Color fundus image: 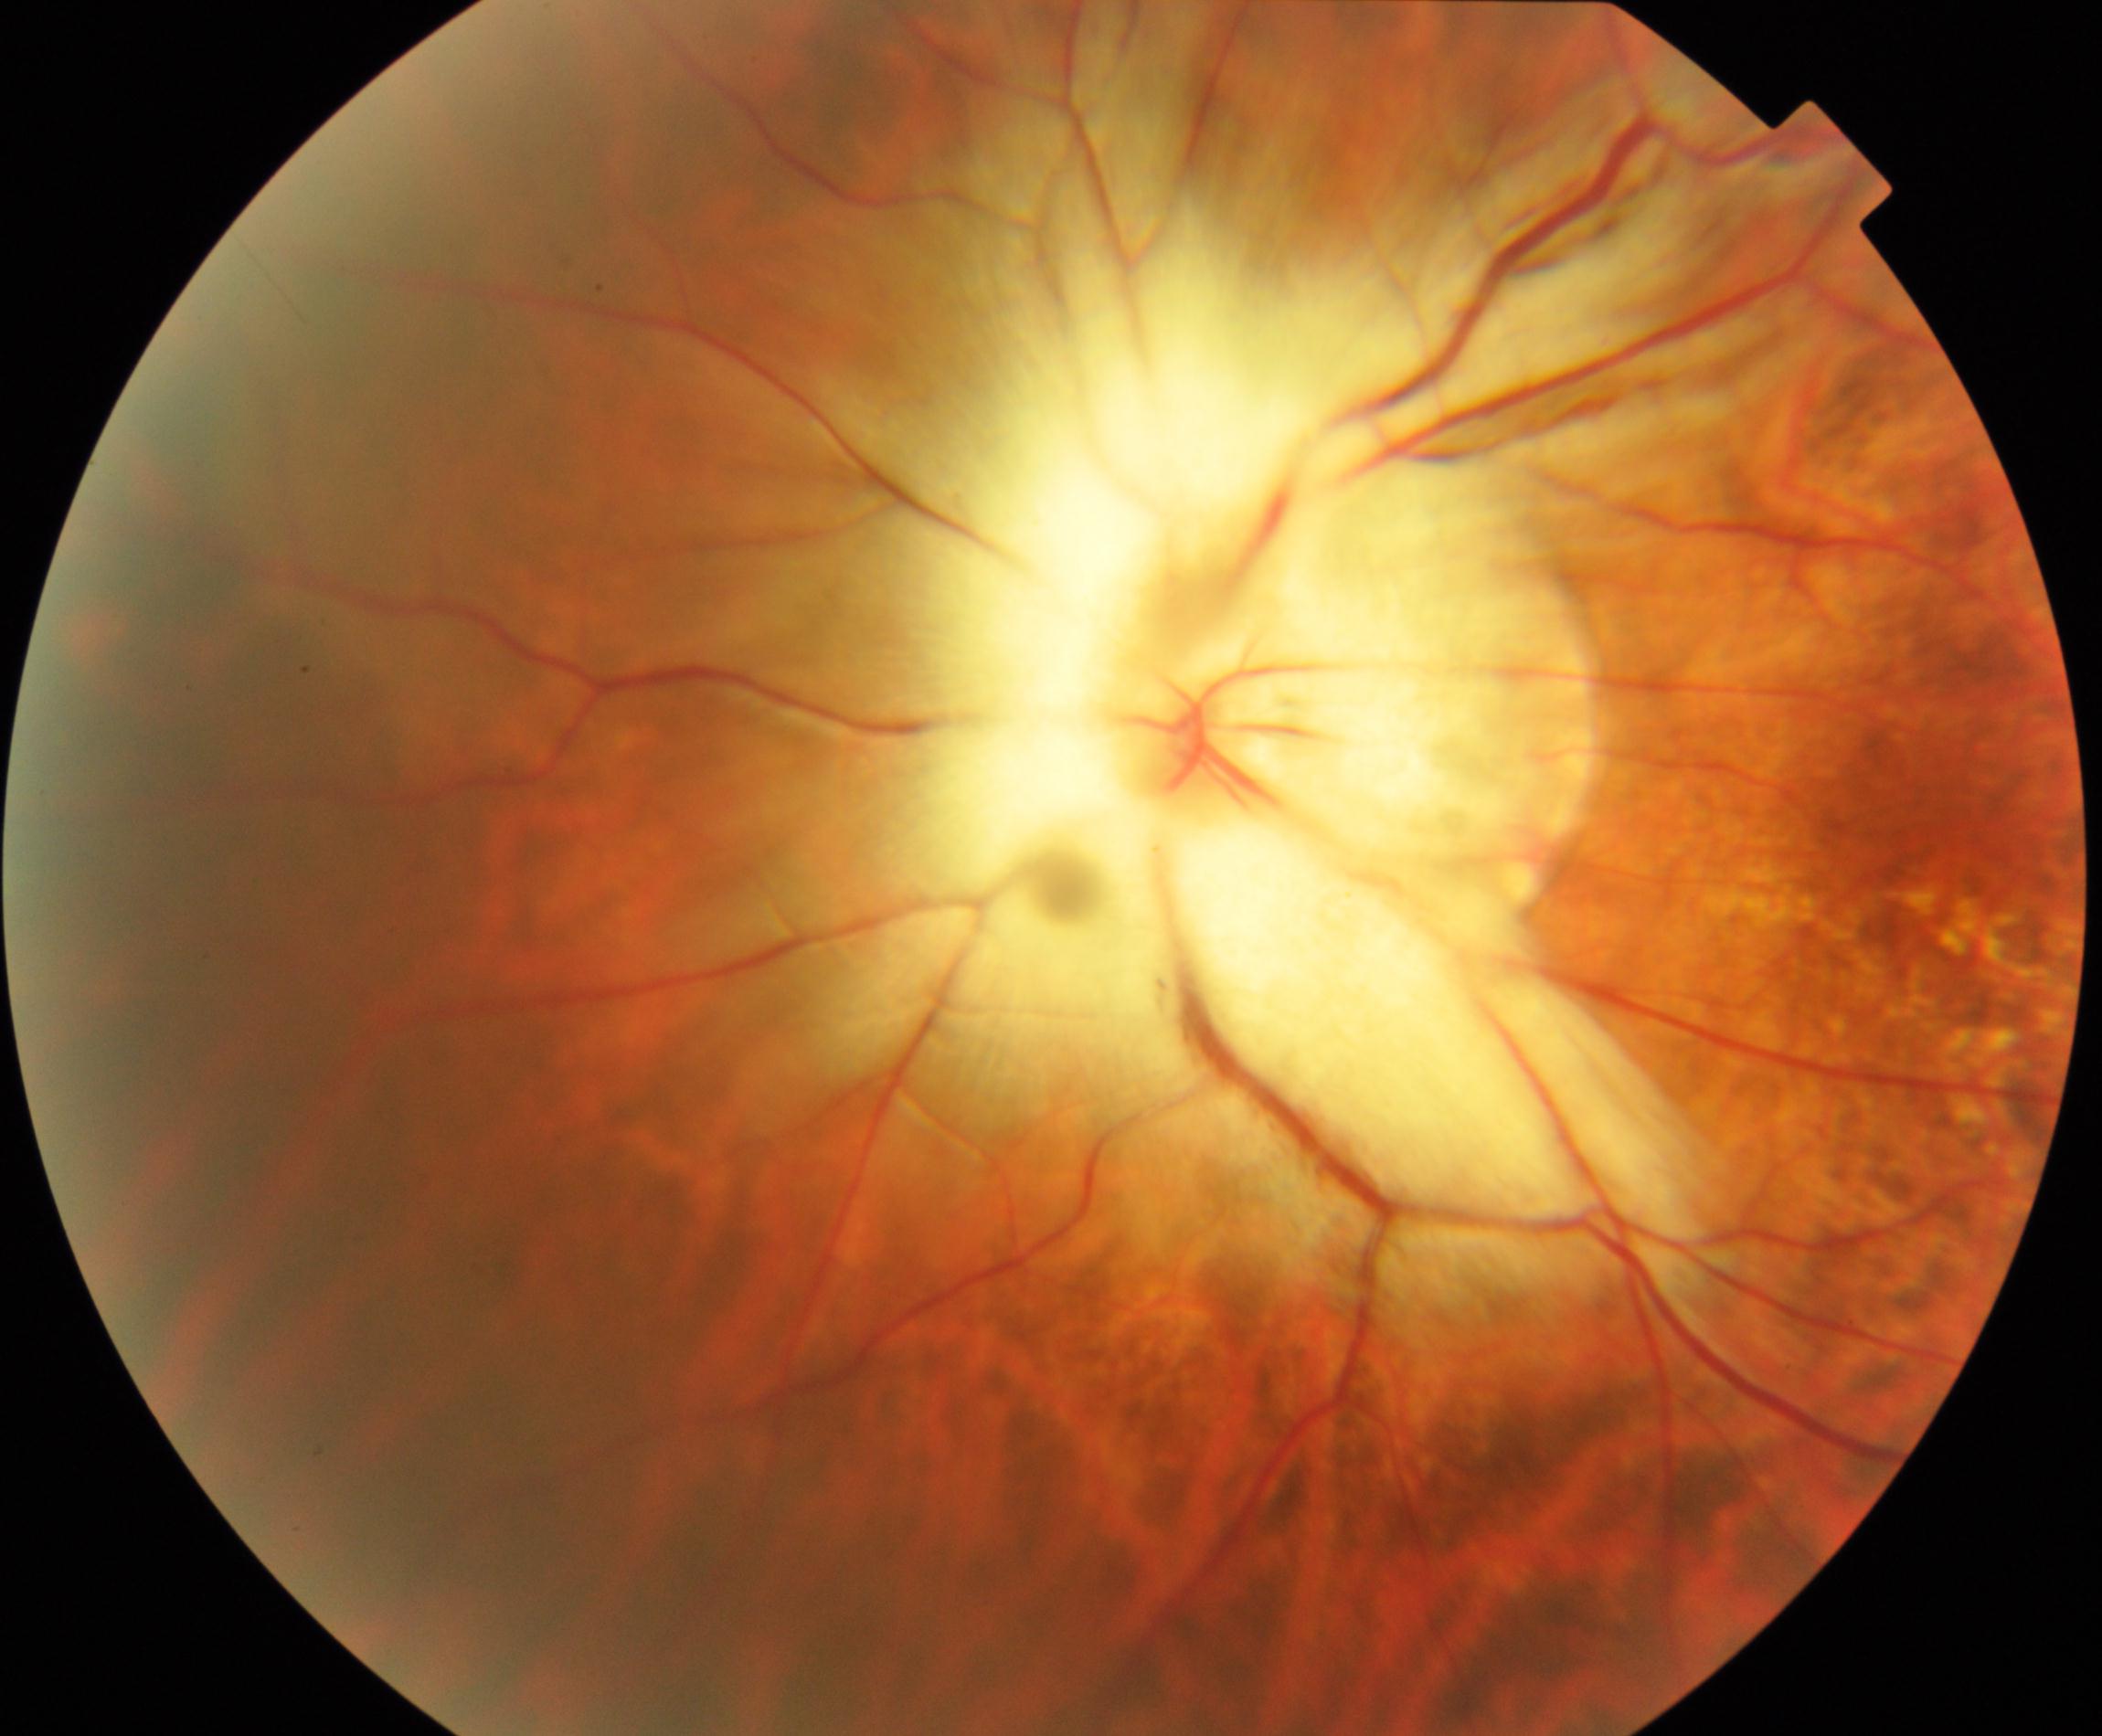

There is evidence of myelinated nerve fibers.